512 by 512 pixels: 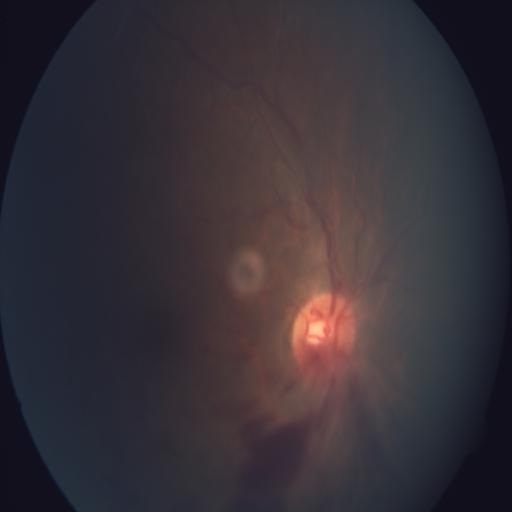
Impression: branch retinal vein occlusion.